2352 x 1568 pixels
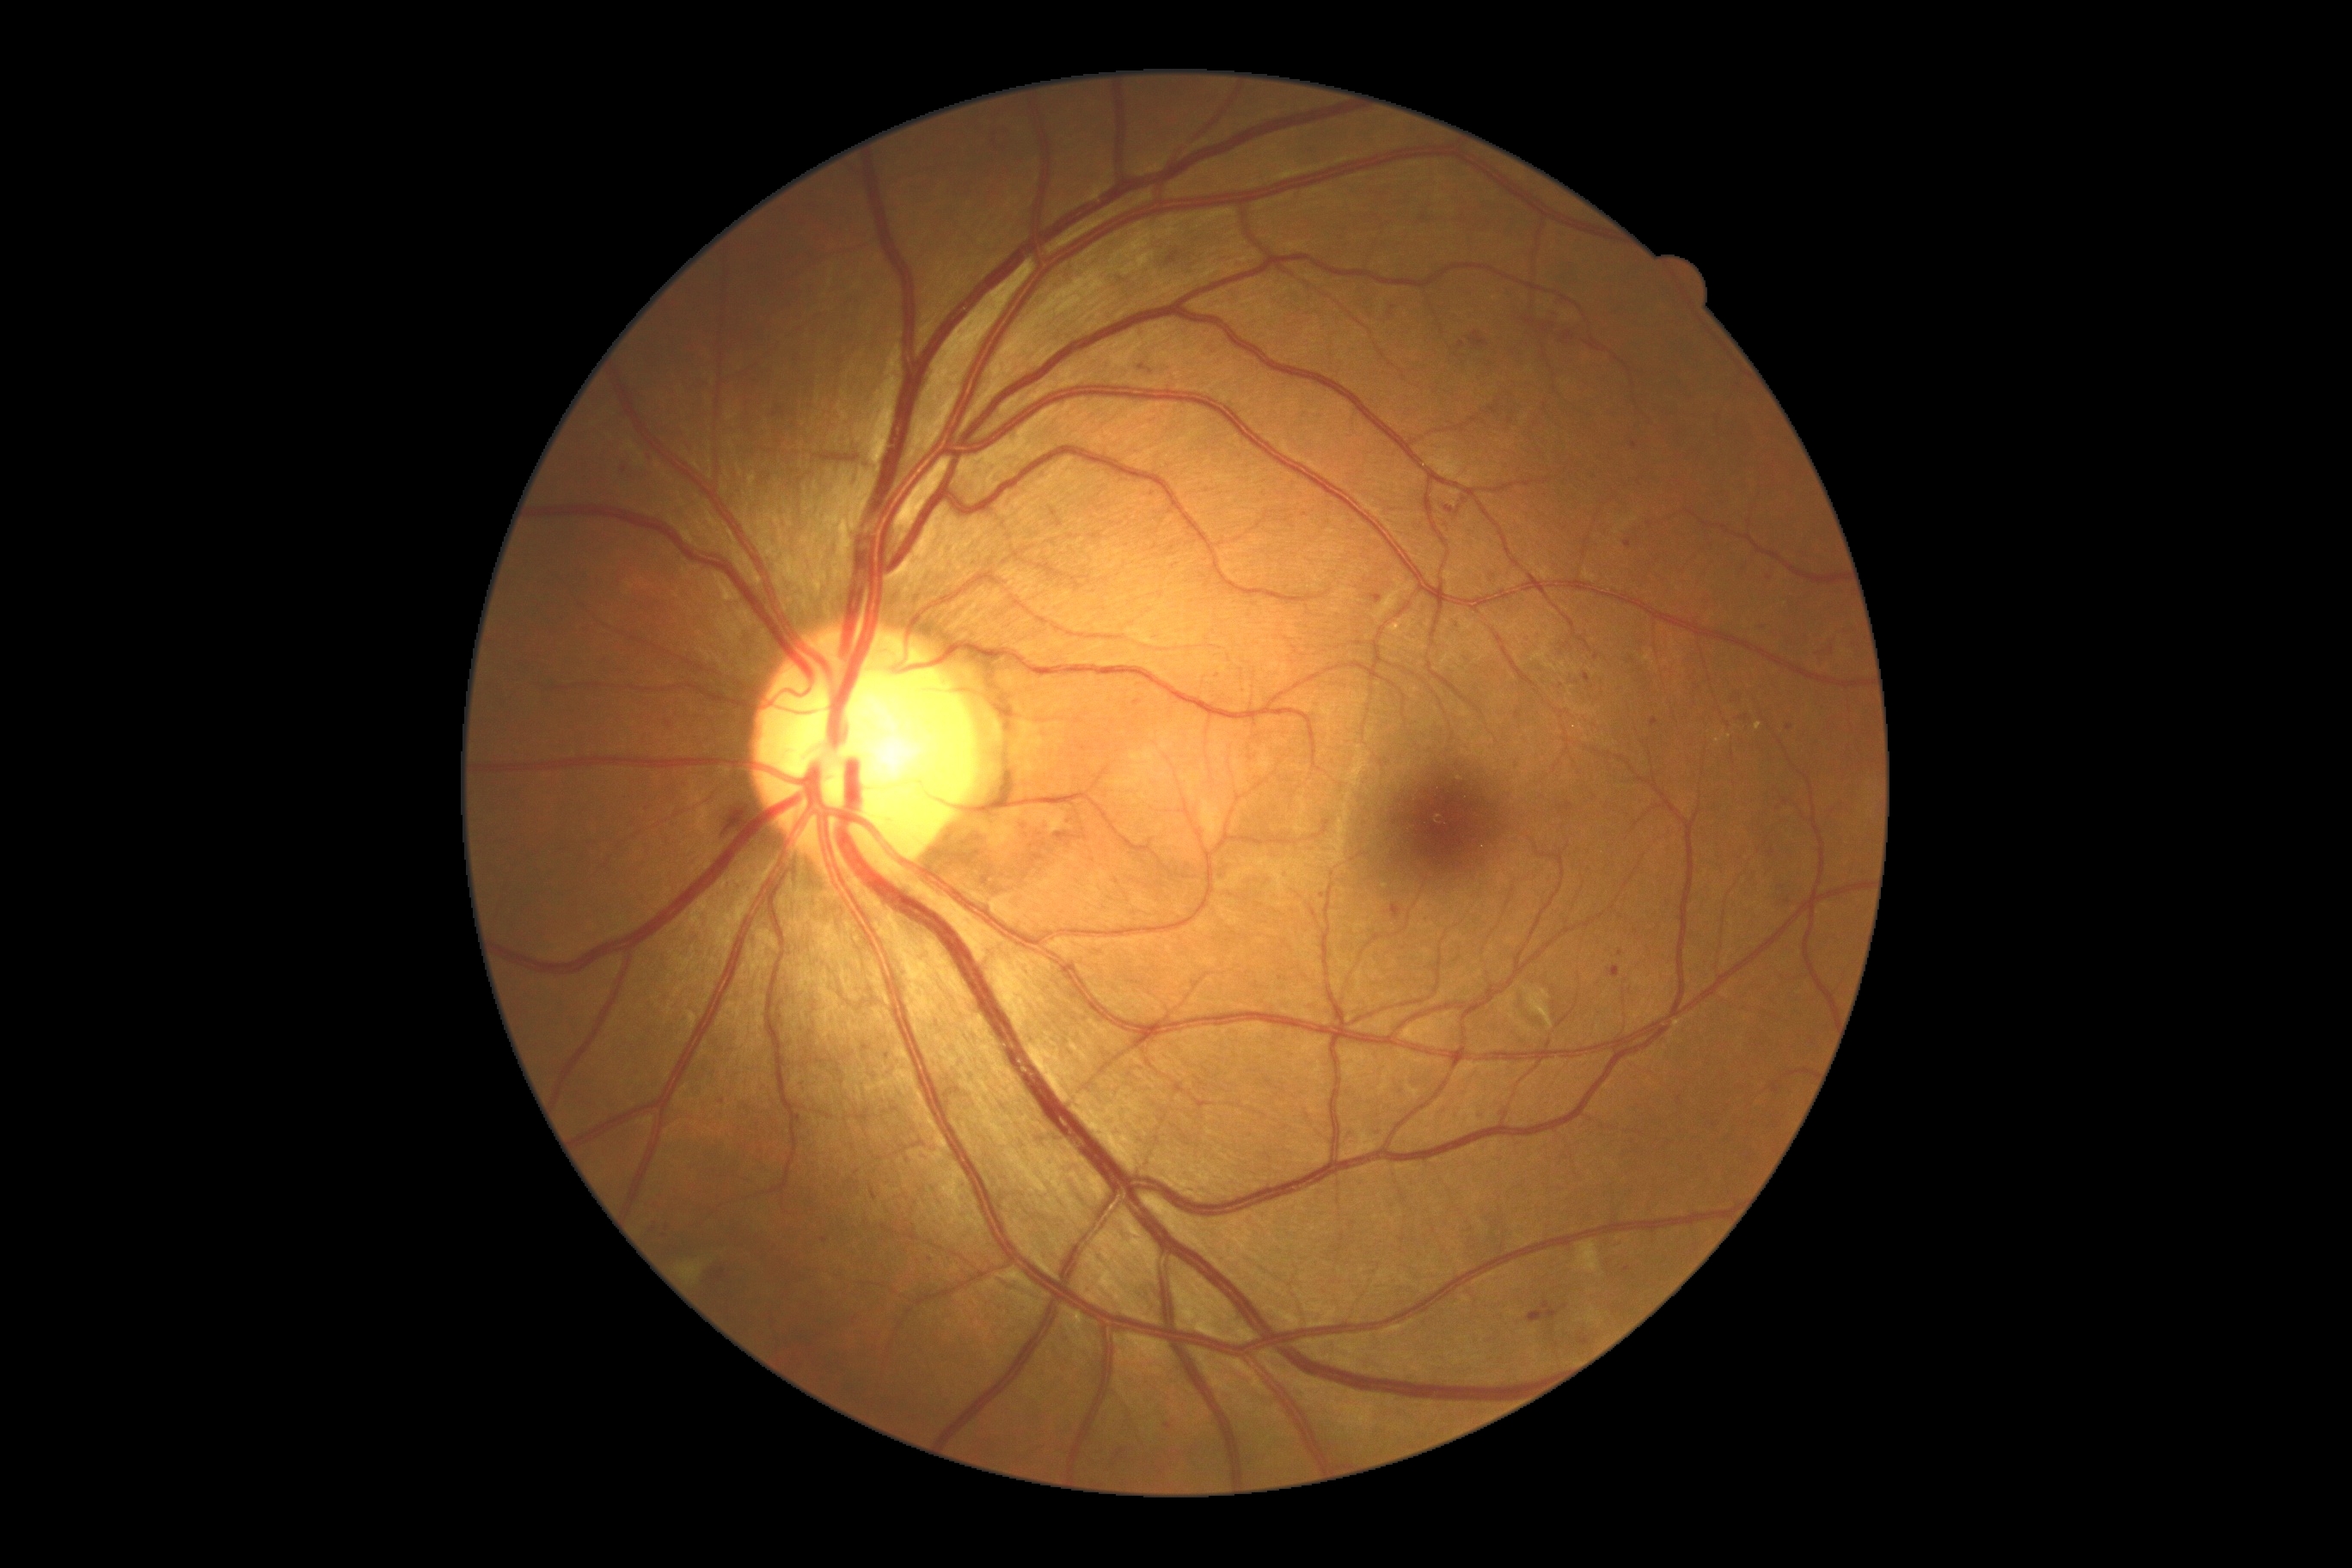 Diabetic retinopathy grade is 2
A subset of detected lesions:
microaneurysms (subset): [1067,818,1074,828], [1583,675,1589,683], [1478,1113,1486,1124], [1167,254,1179,266], [1579,1337,1589,1347], [1445,505,1462,517]
Smaller microaneurysms around x=1564 y=1307, x=1782 y=889, x=1769 y=578, x=655 y=1223, x=1786 y=802, x=1323 y=895, x=723 y=1102, x=1142 y=369, x=1741 y=719